Fundus photo, image size 2346x1568: 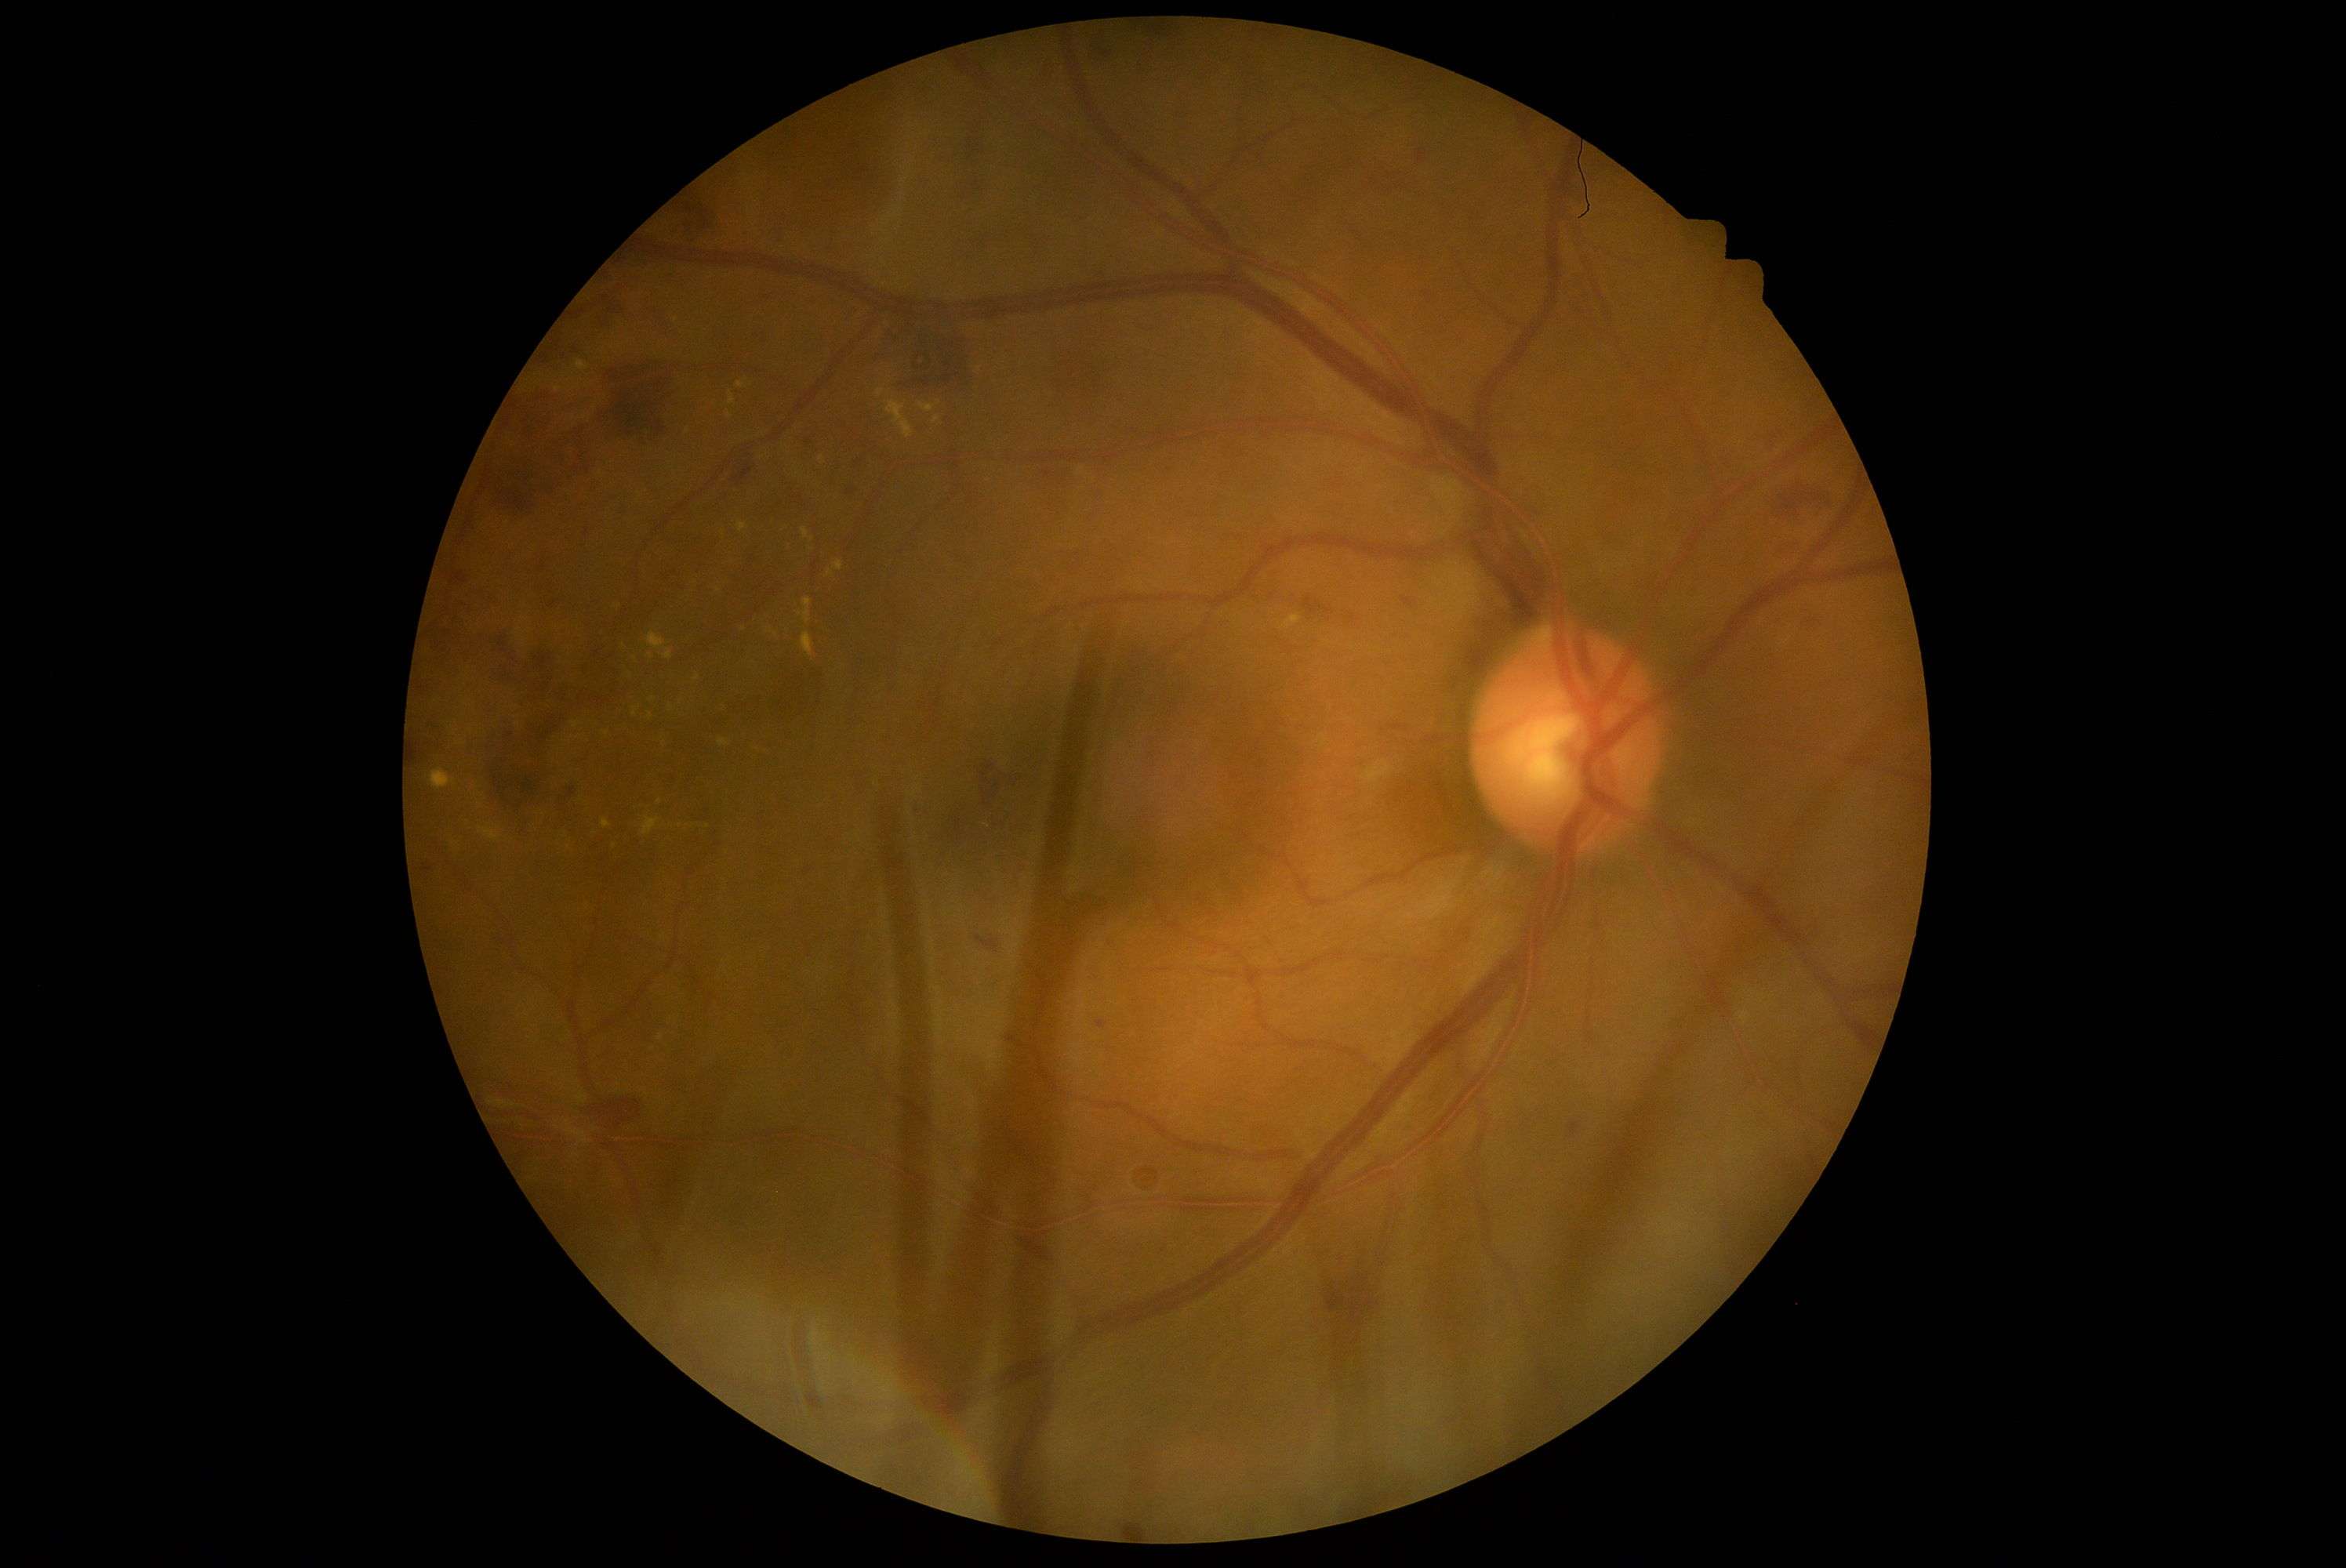

diabetic retinopathy = moderate non-proliferative diabetic retinopathy (grade 2).